CFP:
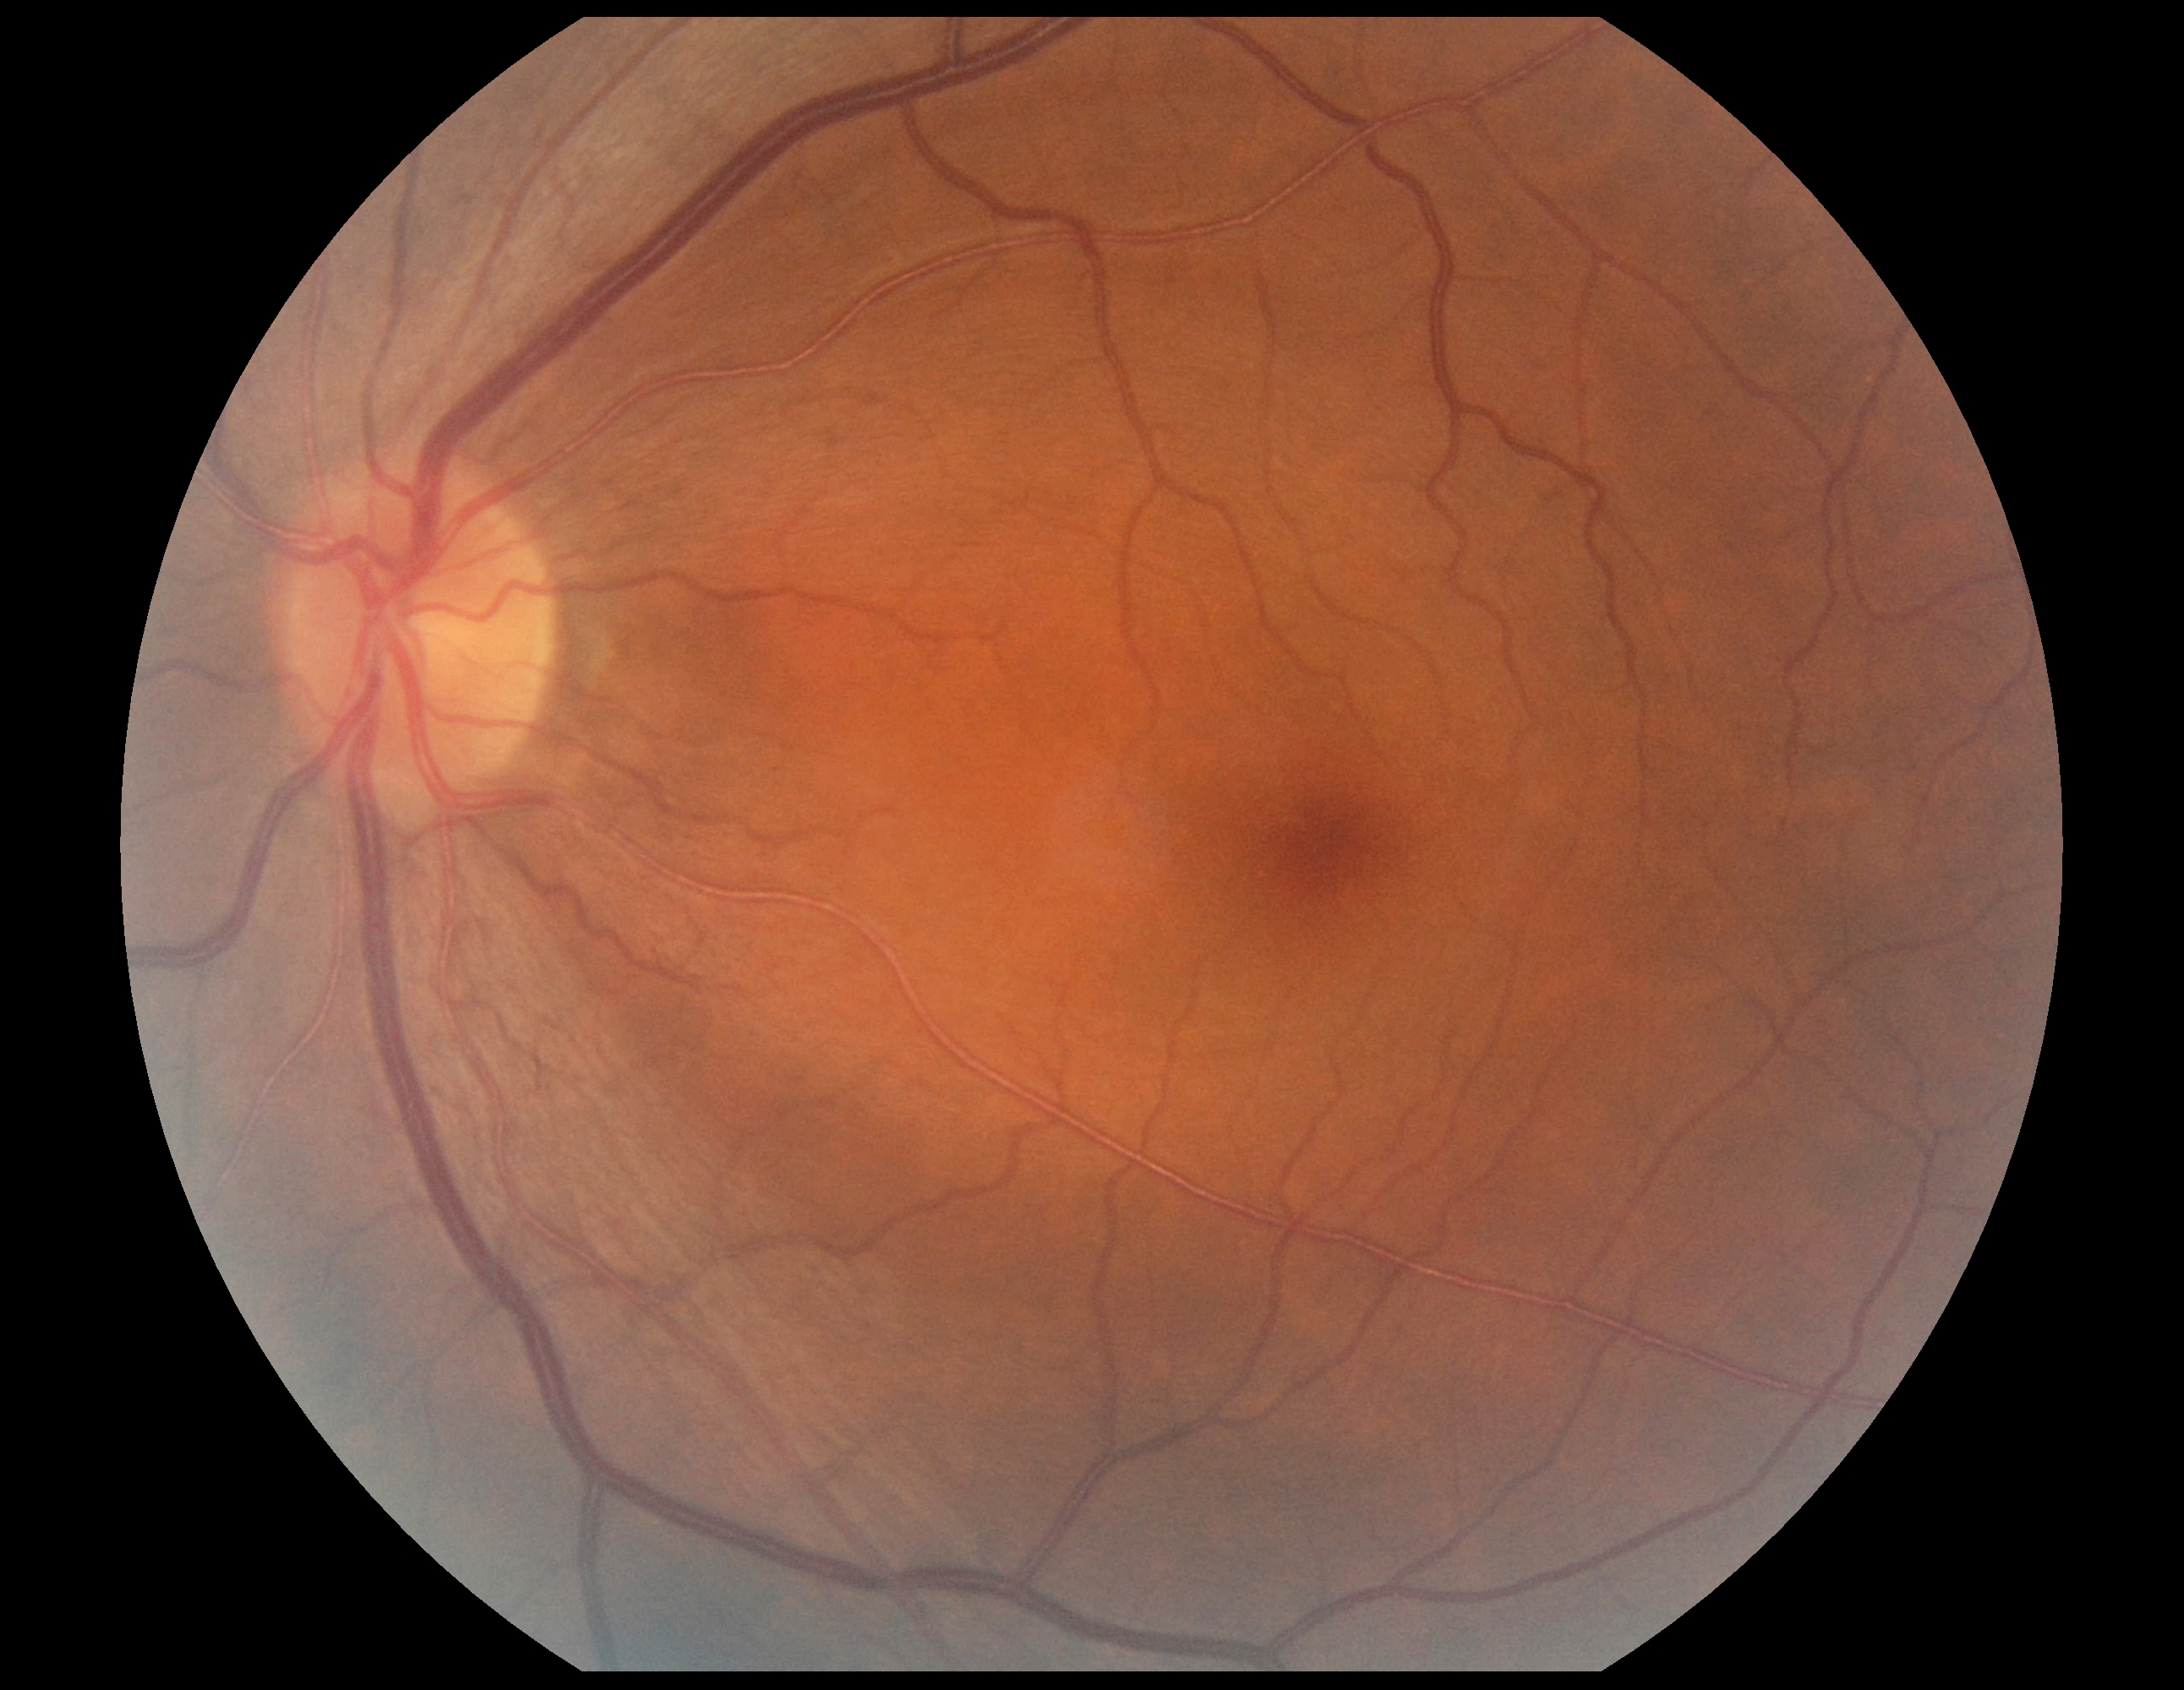 {"dr_impression": "no DR findings", "dr_grade": "grade 0"}